Camera: NIDEK AFC-230, 848 x 848 pixels.
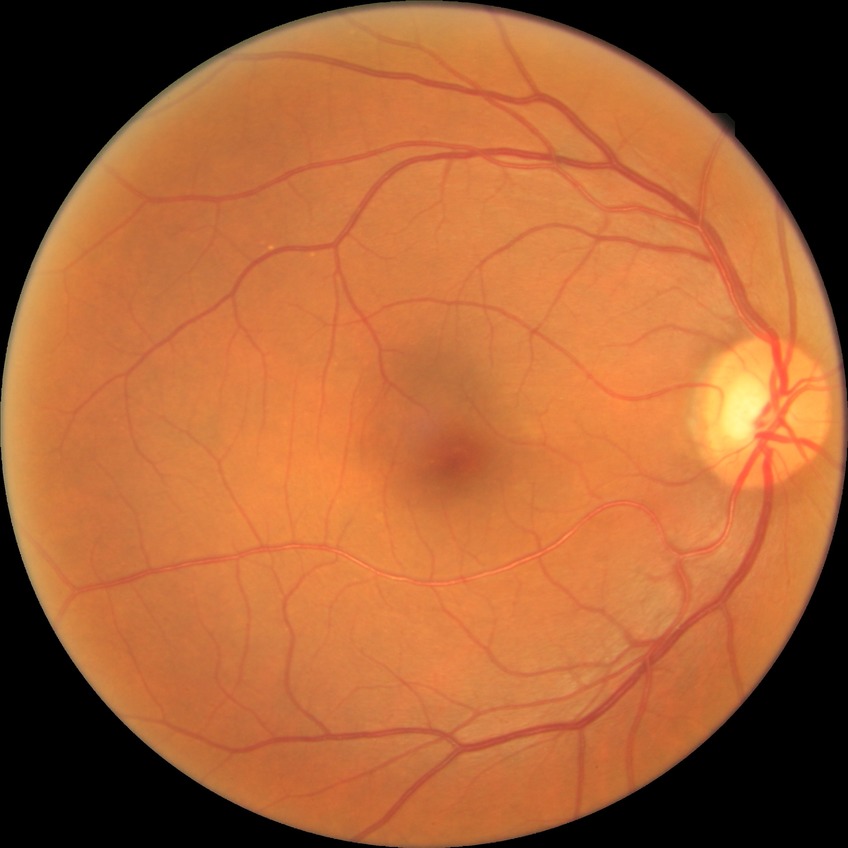
retinopathy stage@simple diabetic retinopathy.